1624 by 1232 pixels.
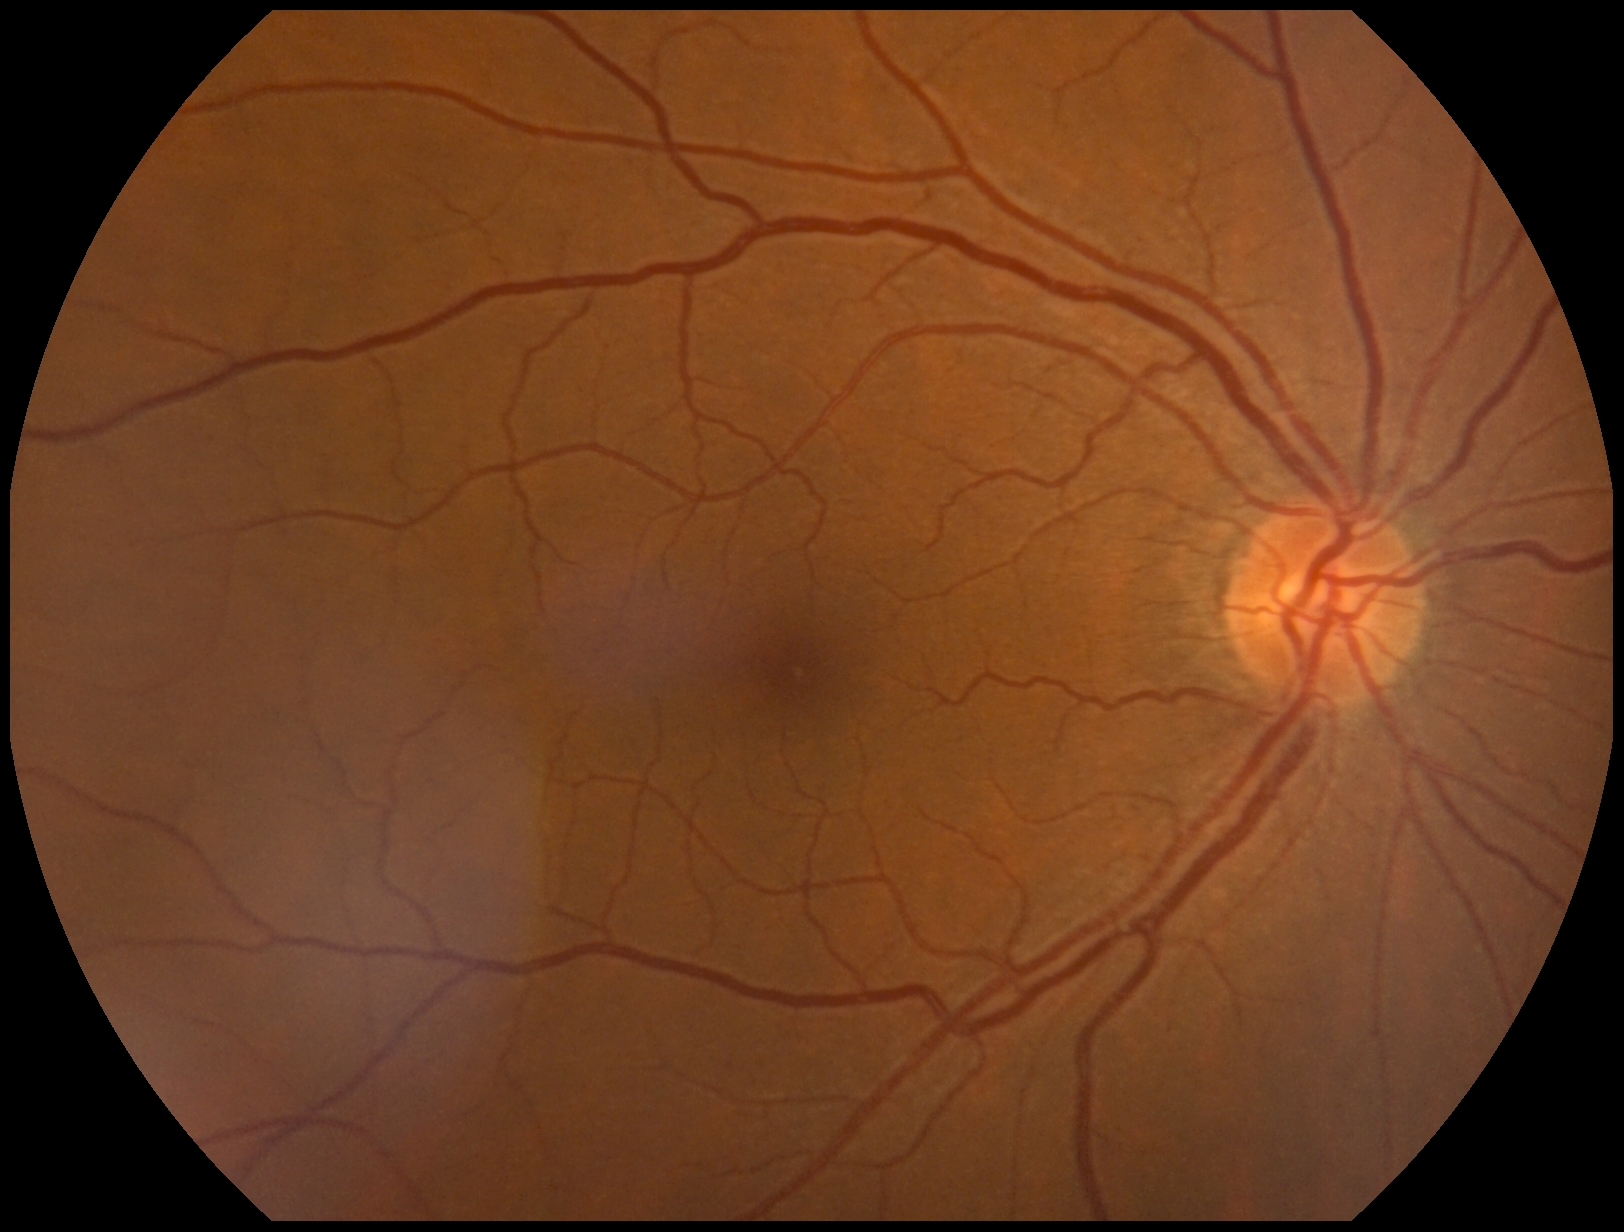

DR stage is grade 0 (no apparent retinopathy).